45 degree fundus photograph, acquired with a NIDEK AFC-230, modified Davis grading, fundus photo — 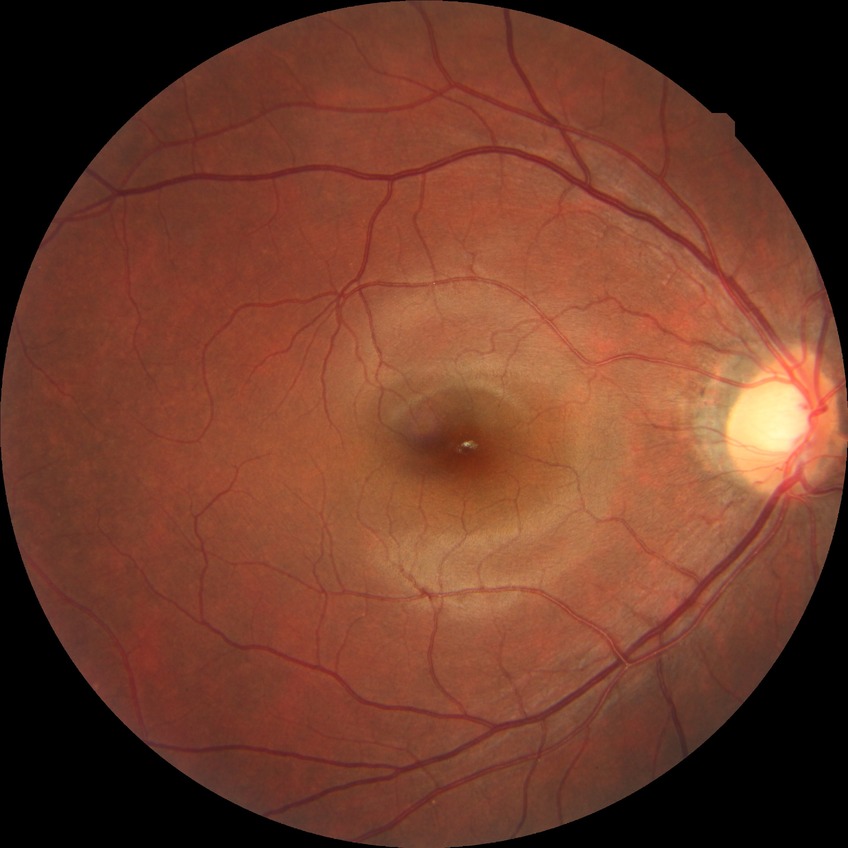
Diabetic retinopathy (DR): NDR (no diabetic retinopathy).